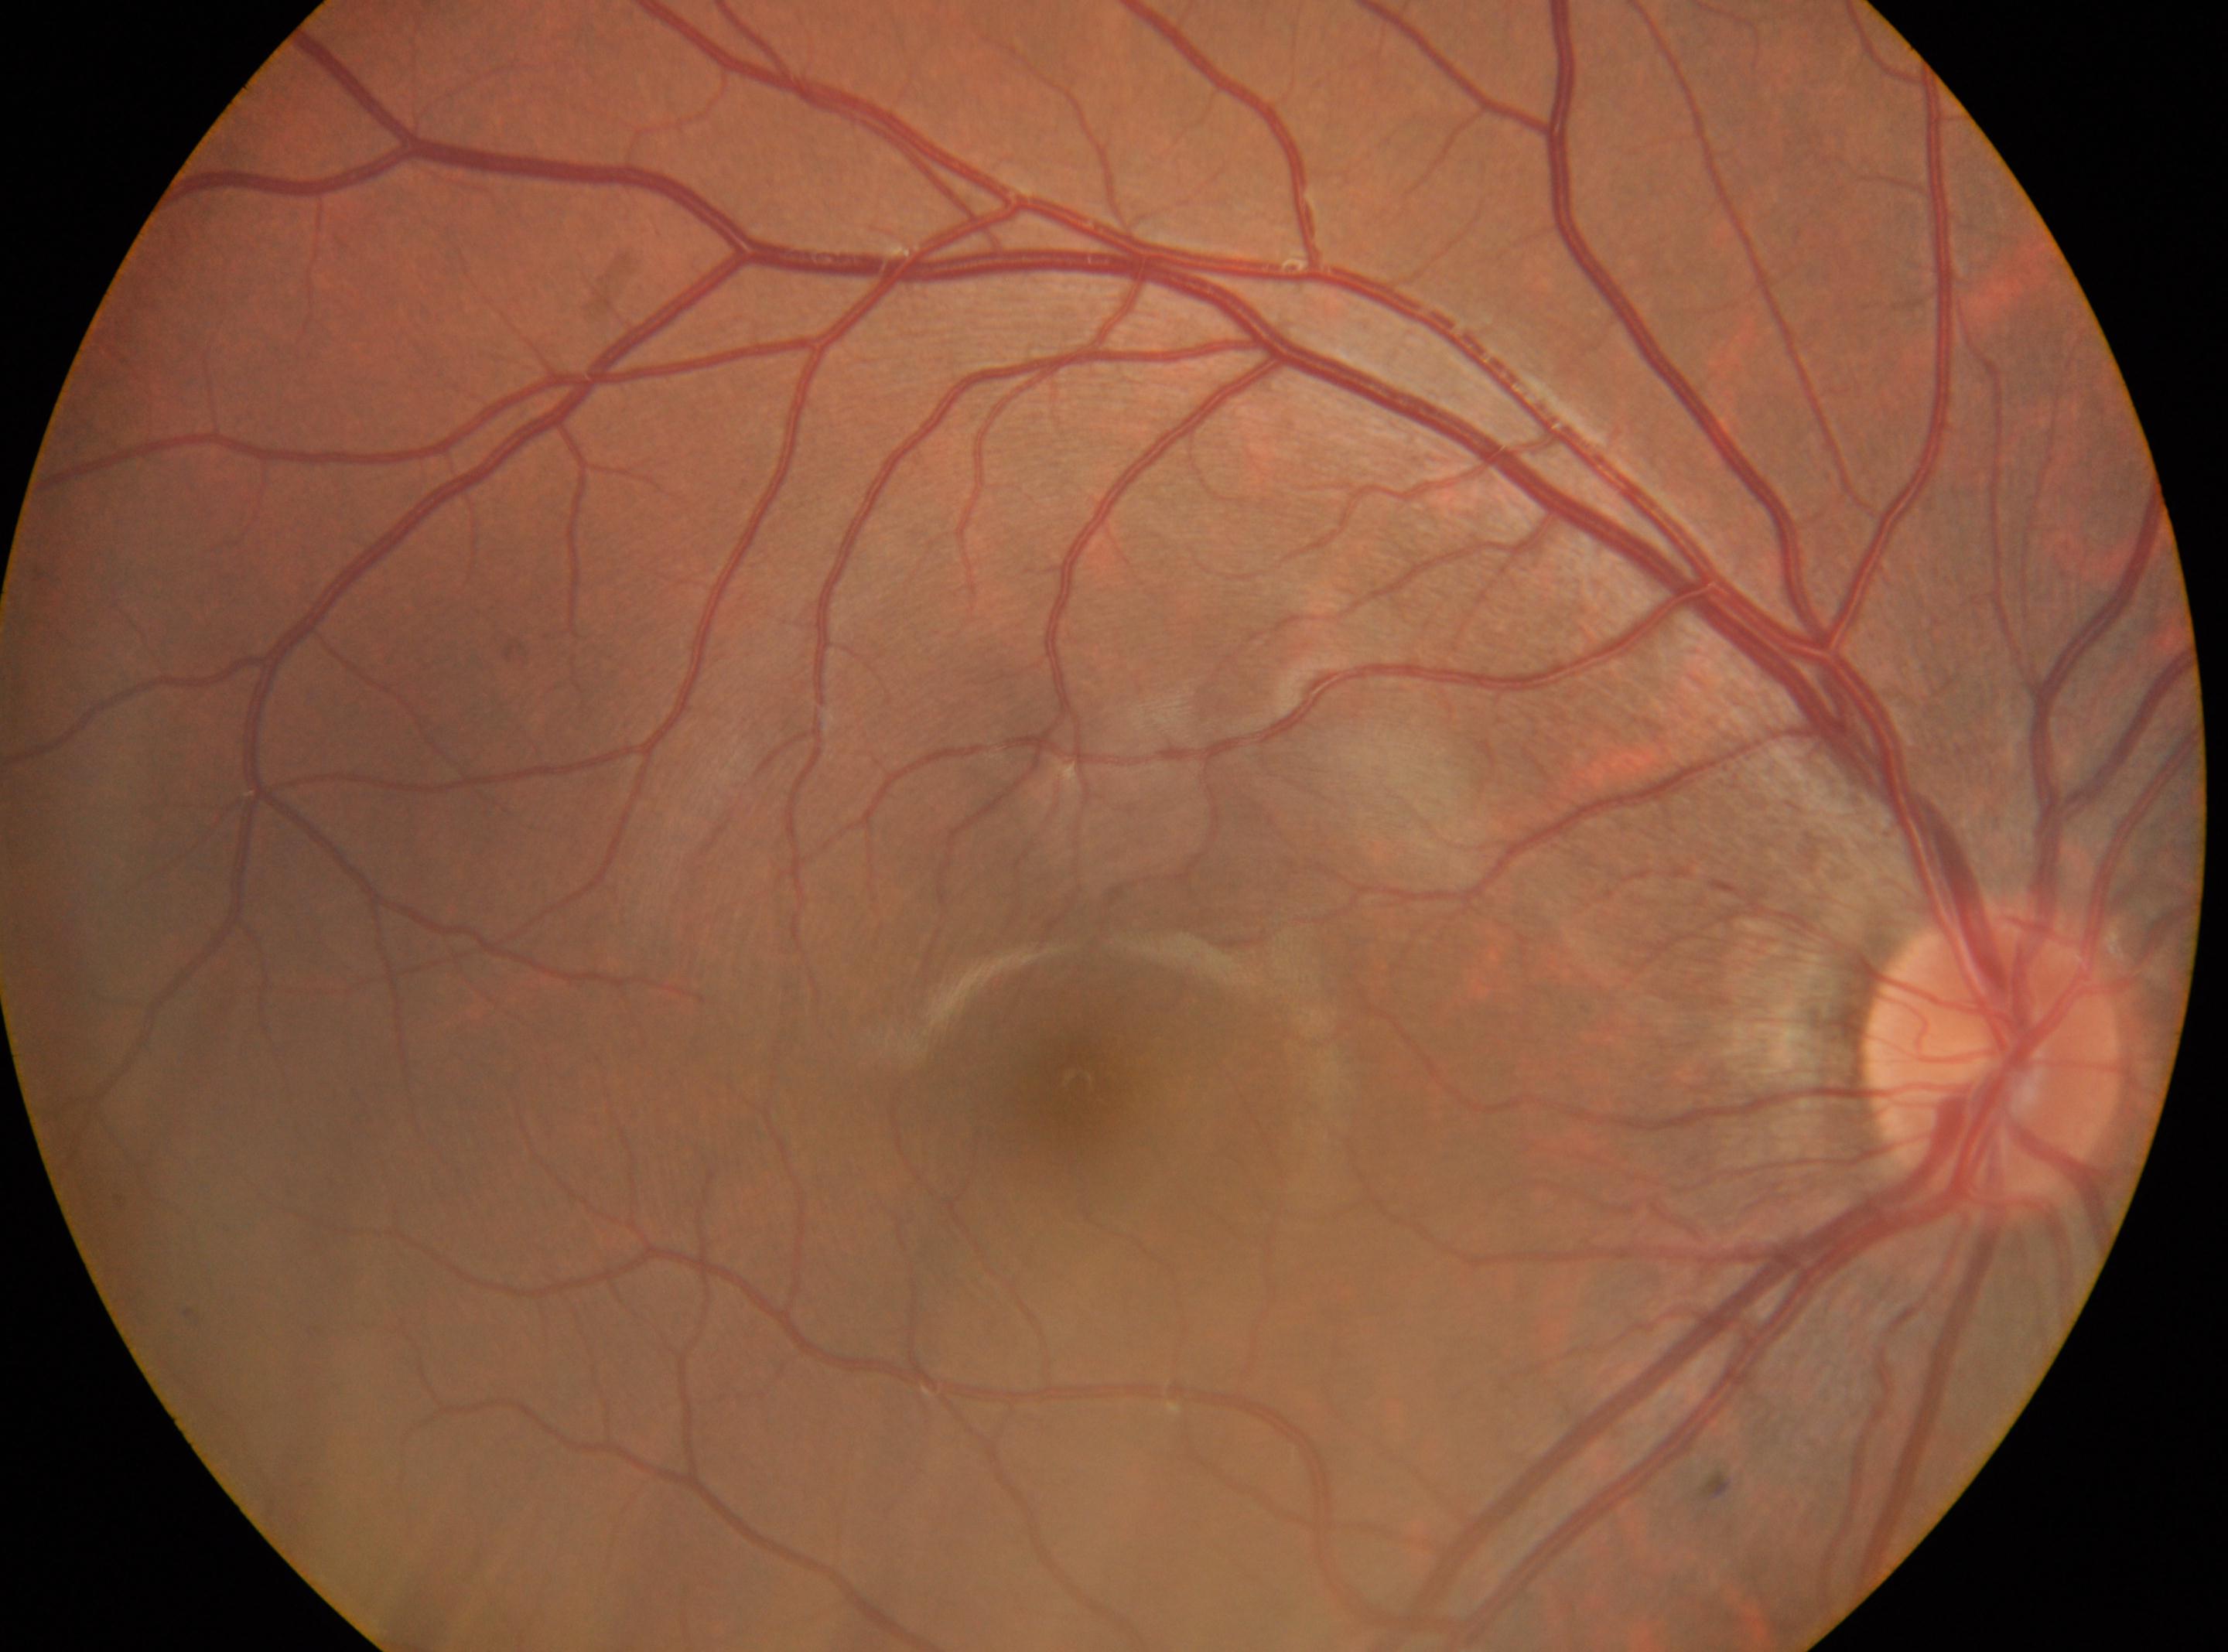
DR grade: no apparent retinopathy (0) — no visible signs of diabetic retinopathy.
Fovea: (1077,1083).
Optic disk located at (1993,1056).
Eye: oculus dexter.
No apparent diabetic retinopathy.